Color fundus image, 45-degree field of view — 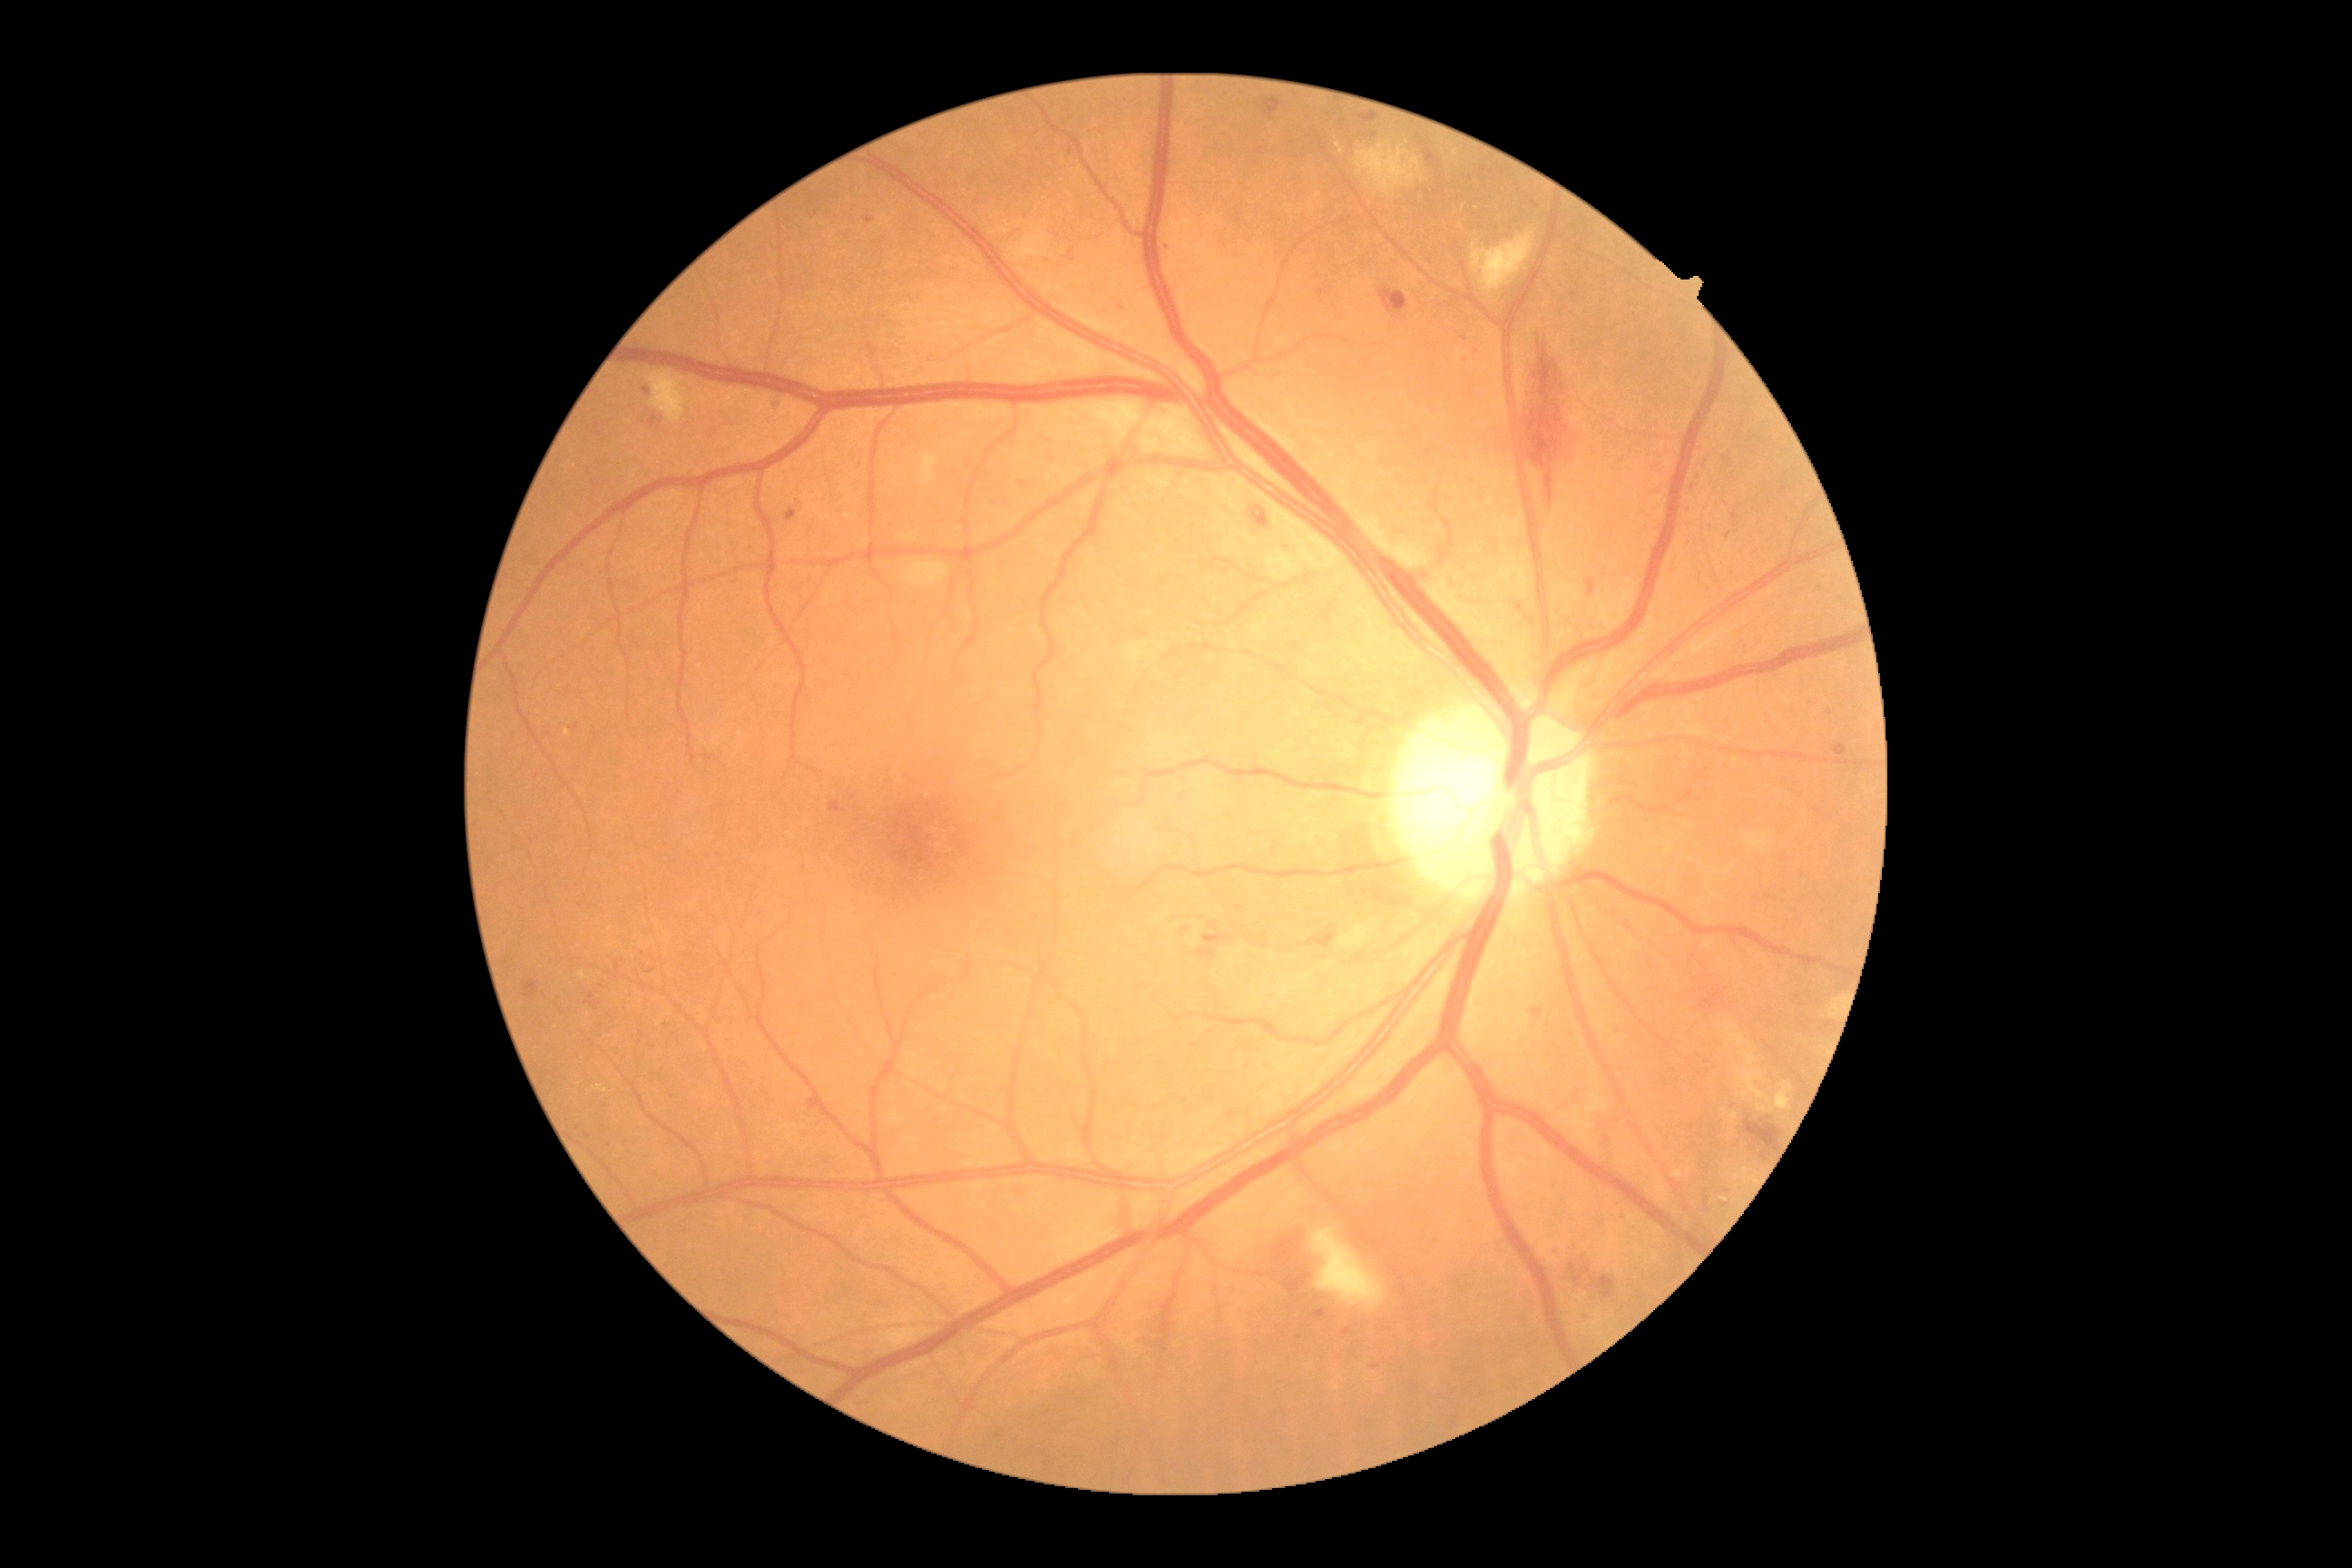

partial: true
dr_grade: 2
lesions:
  ma:
    - 524 981 538 999
    - 1164 246 1173 251
    - 785 509 798 522
    - 643 387 651 397
    - 1342 1328 1353 1335
    - 1046 255 1054 260
    - 807 1101 819 1110
    - 1705 1191 1709 1206
  ma_small_centers:
    - <point>775, 405</point>
    - <point>1239, 908</point>
    - <point>1727, 1205</point>
    - <point>589, 1137</point>
    - <point>1727, 536</point>
    - <point>1022, 485</point>